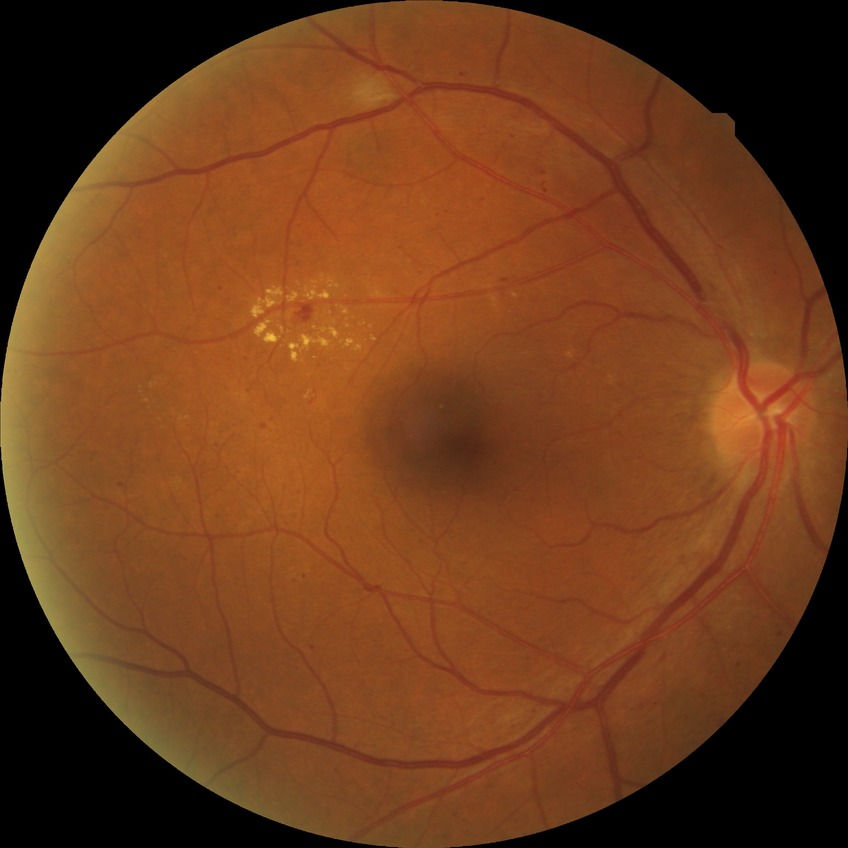

Diabetic retinopathy (DR) is SDR (simple diabetic retinopathy).